Fundus image cropped to the optic disc:
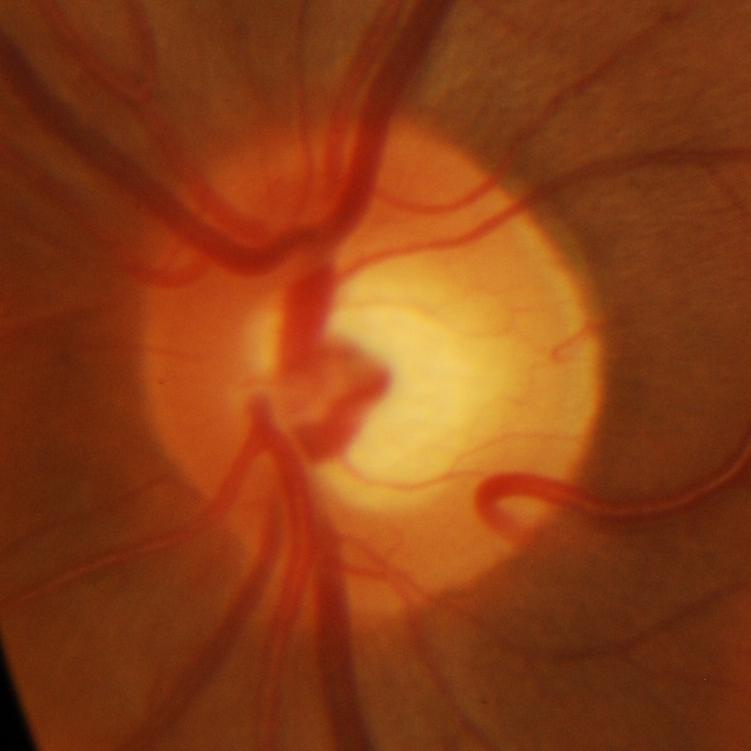
Impression = glaucomatous changes.